Wide-field fundus photograph from neonatal ROP screening. Camera: Phoenix ICON (100° FOV):
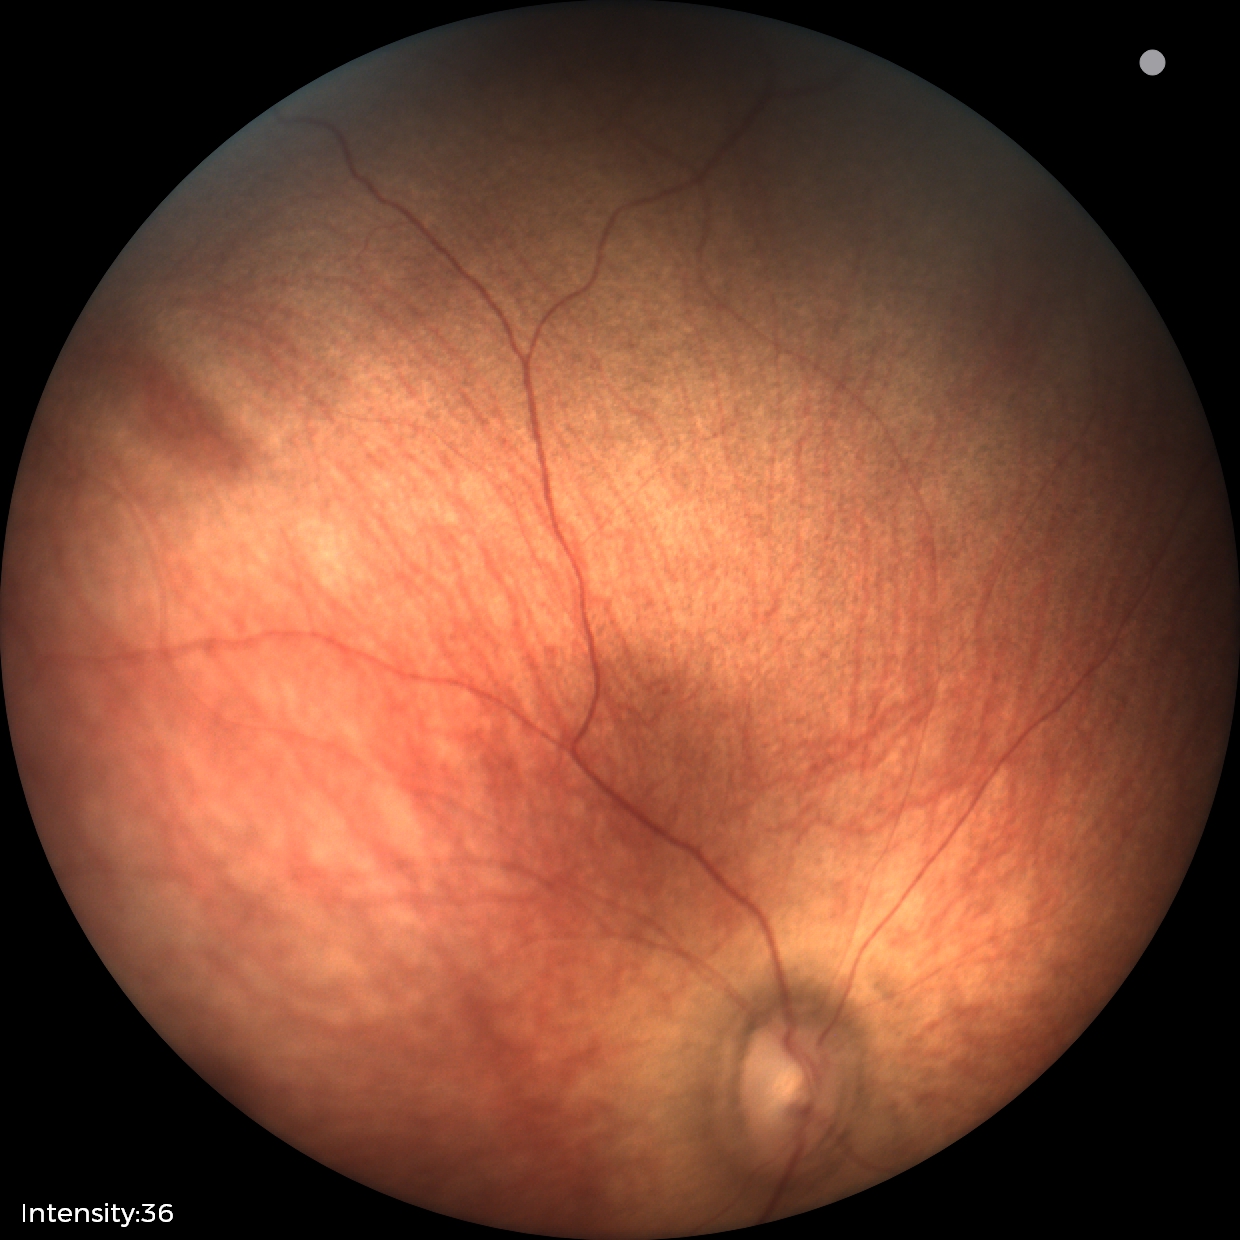 Physiological retinal appearance for postconceptual age.